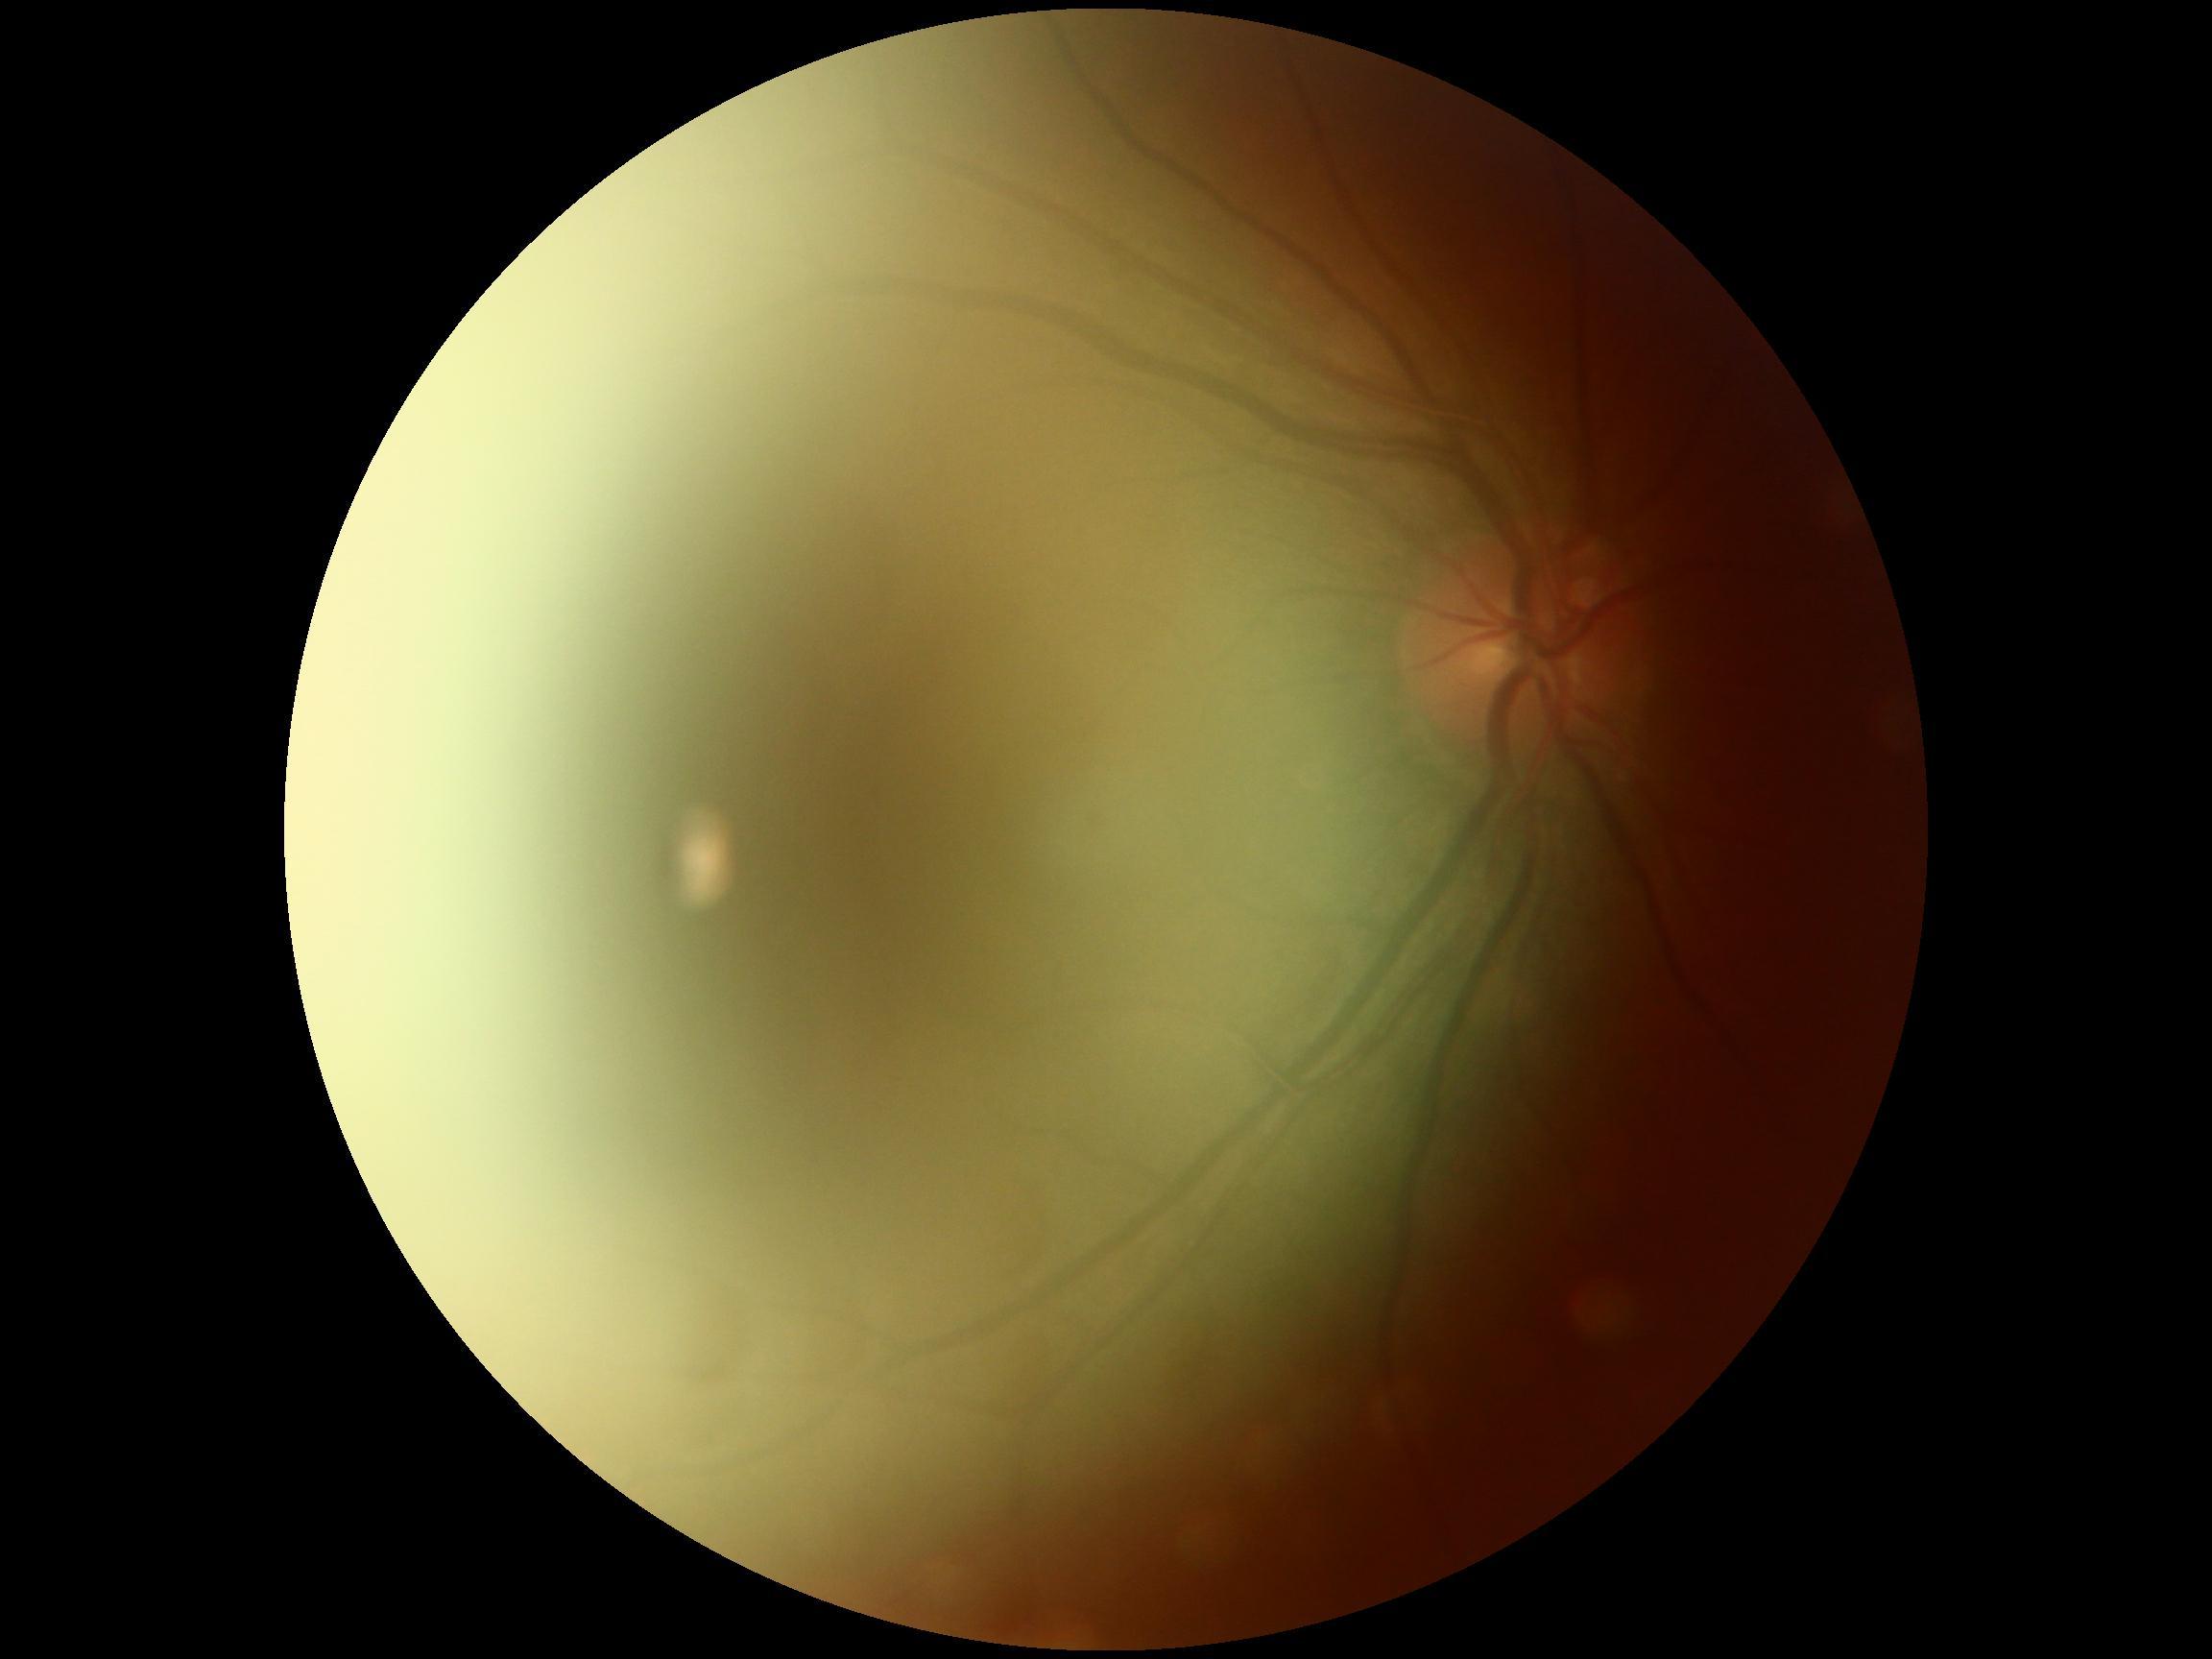
Retinopathy is ungradable due to poor image quality.